Fundus photo: 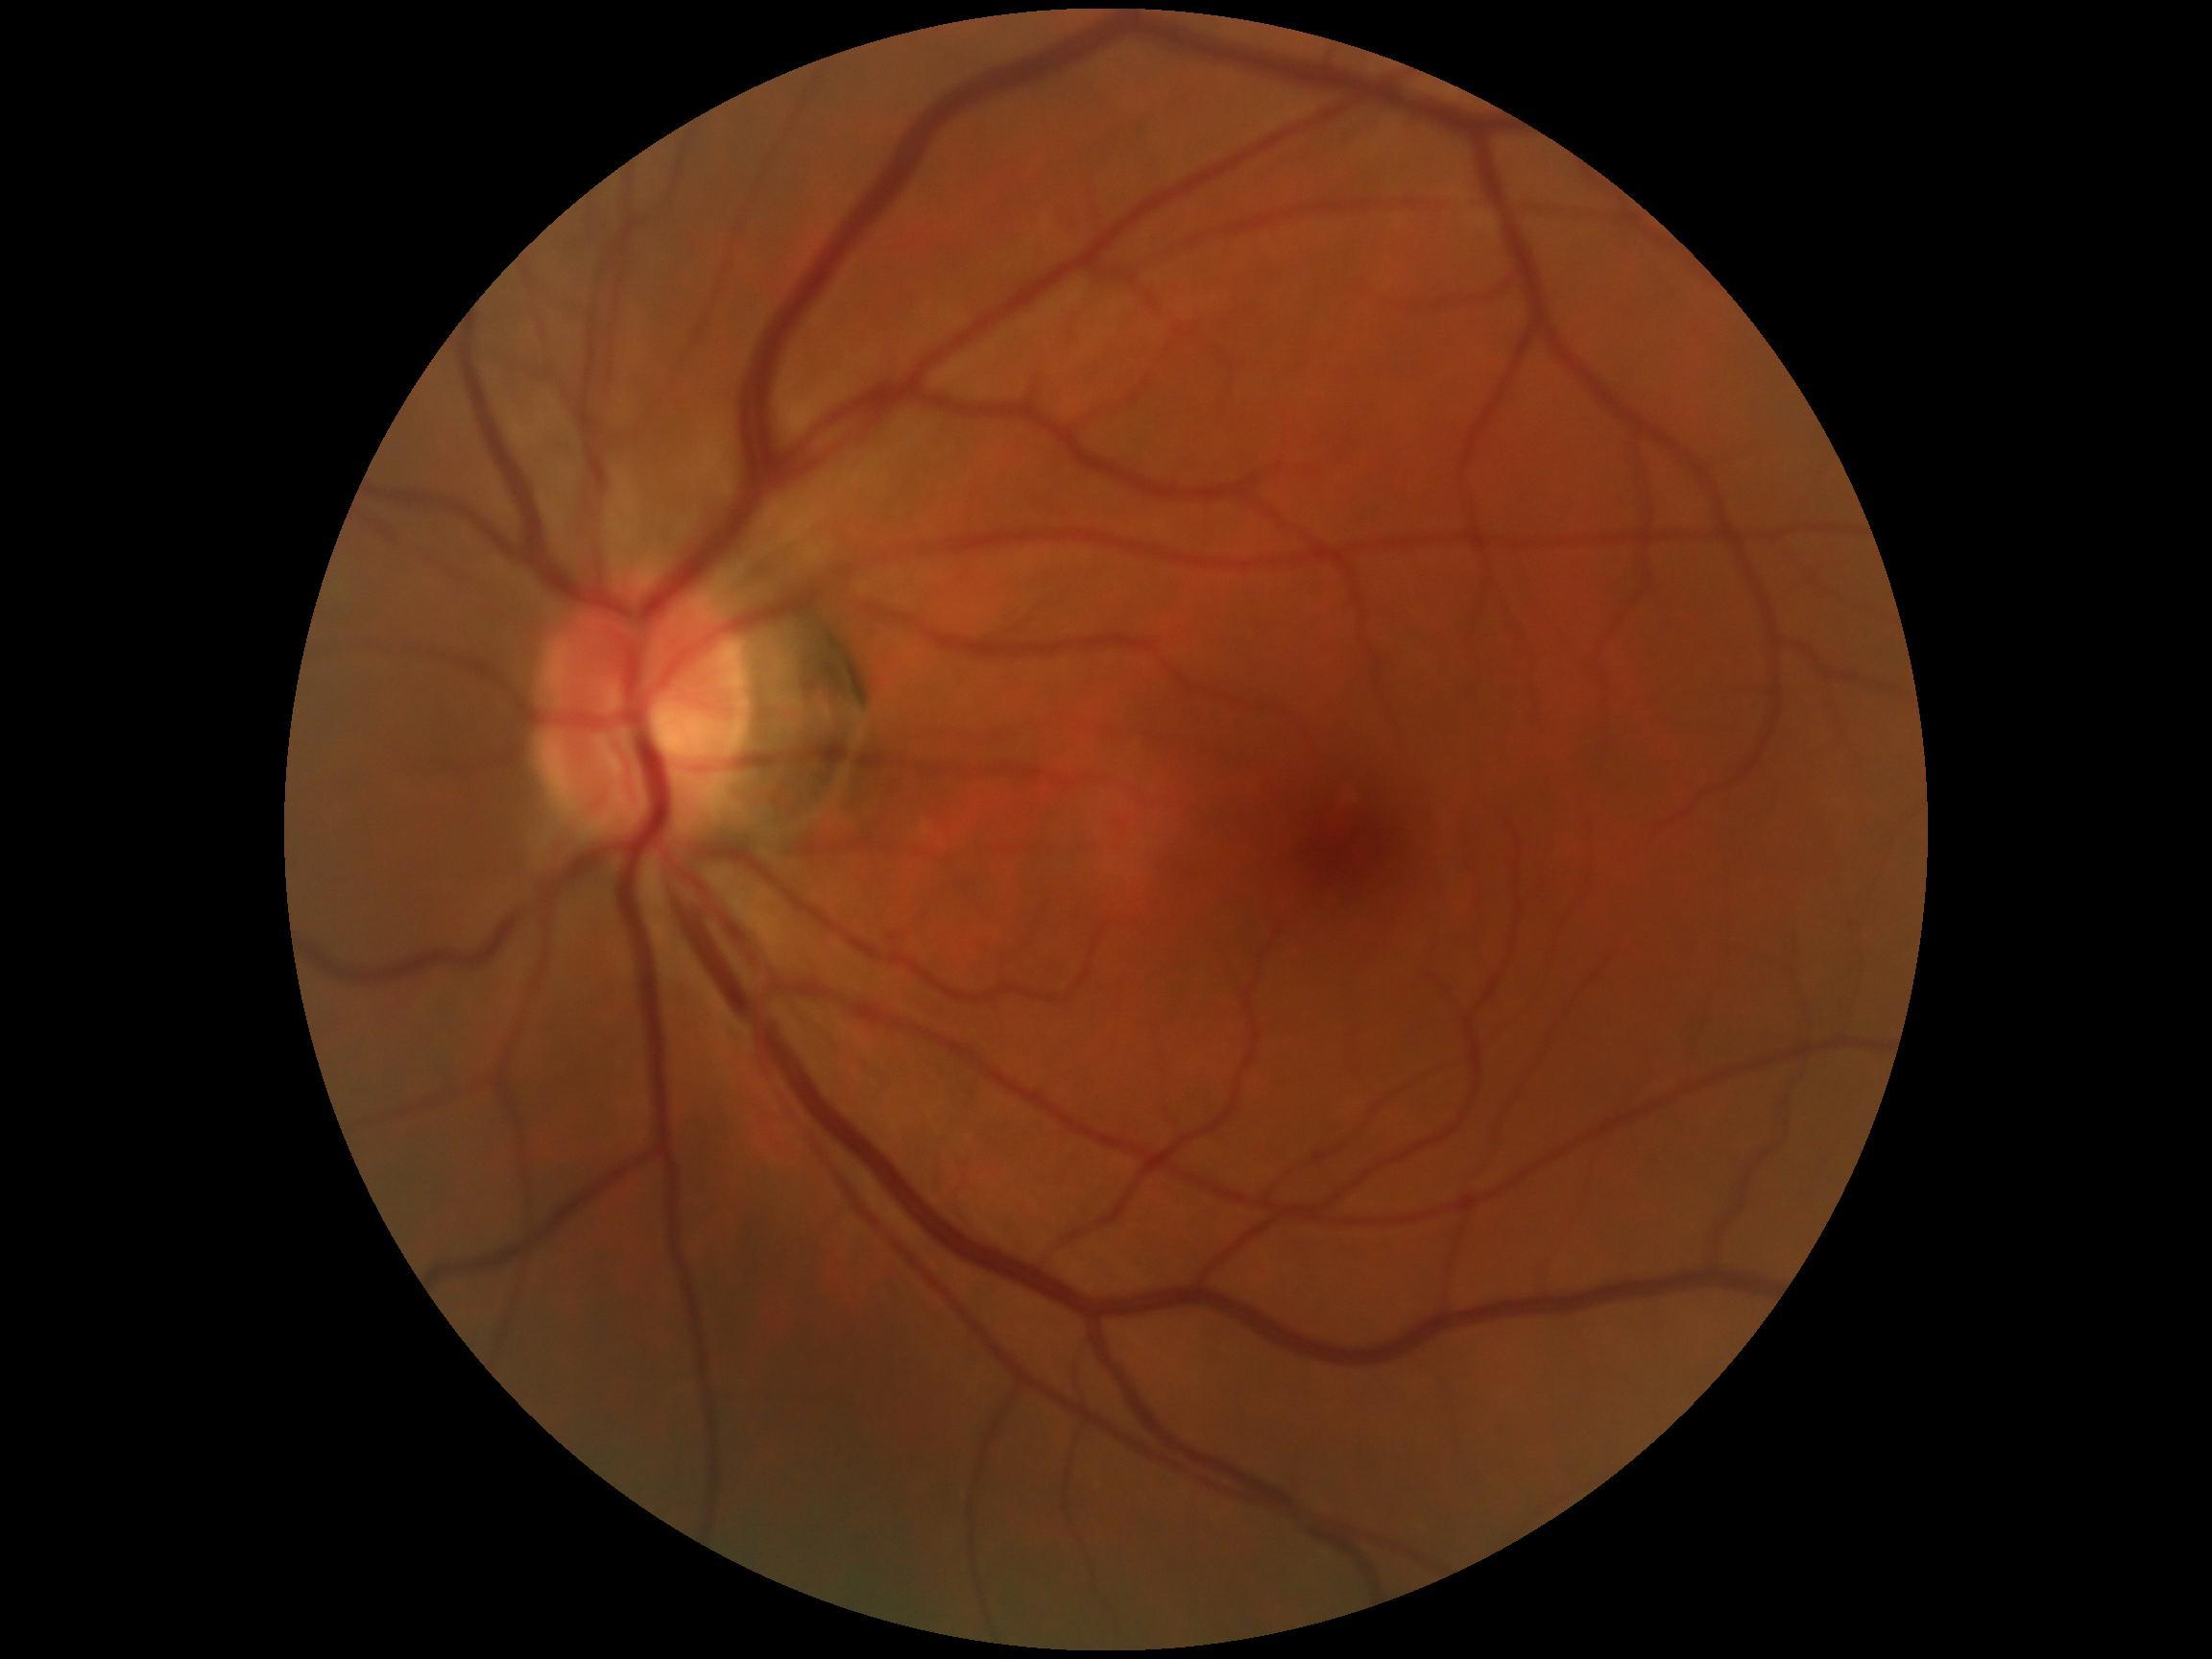
diabetic retinopathy (DR)=no apparent retinopathy (grade 0).